Infant wide-field fundus photograph — 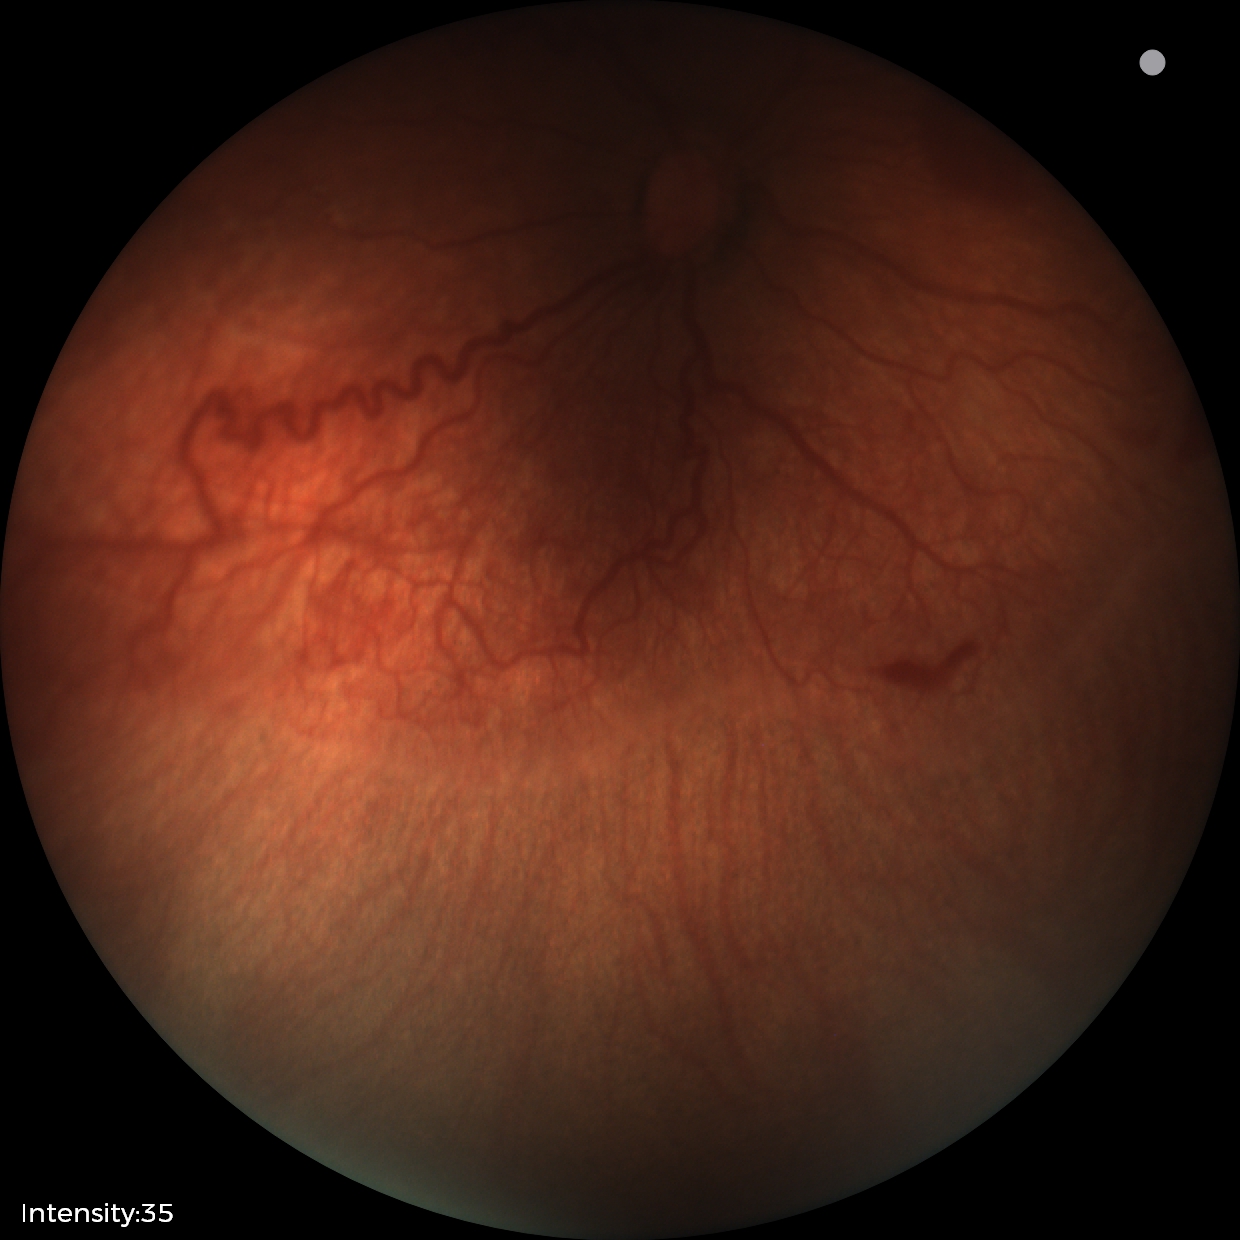 Plus disease = present, screening diagnosis = retinopathy of prematurity (ROP) stage 2.